Acquired on the Phoenix ICON. Pediatric wide-field fundus photograph.
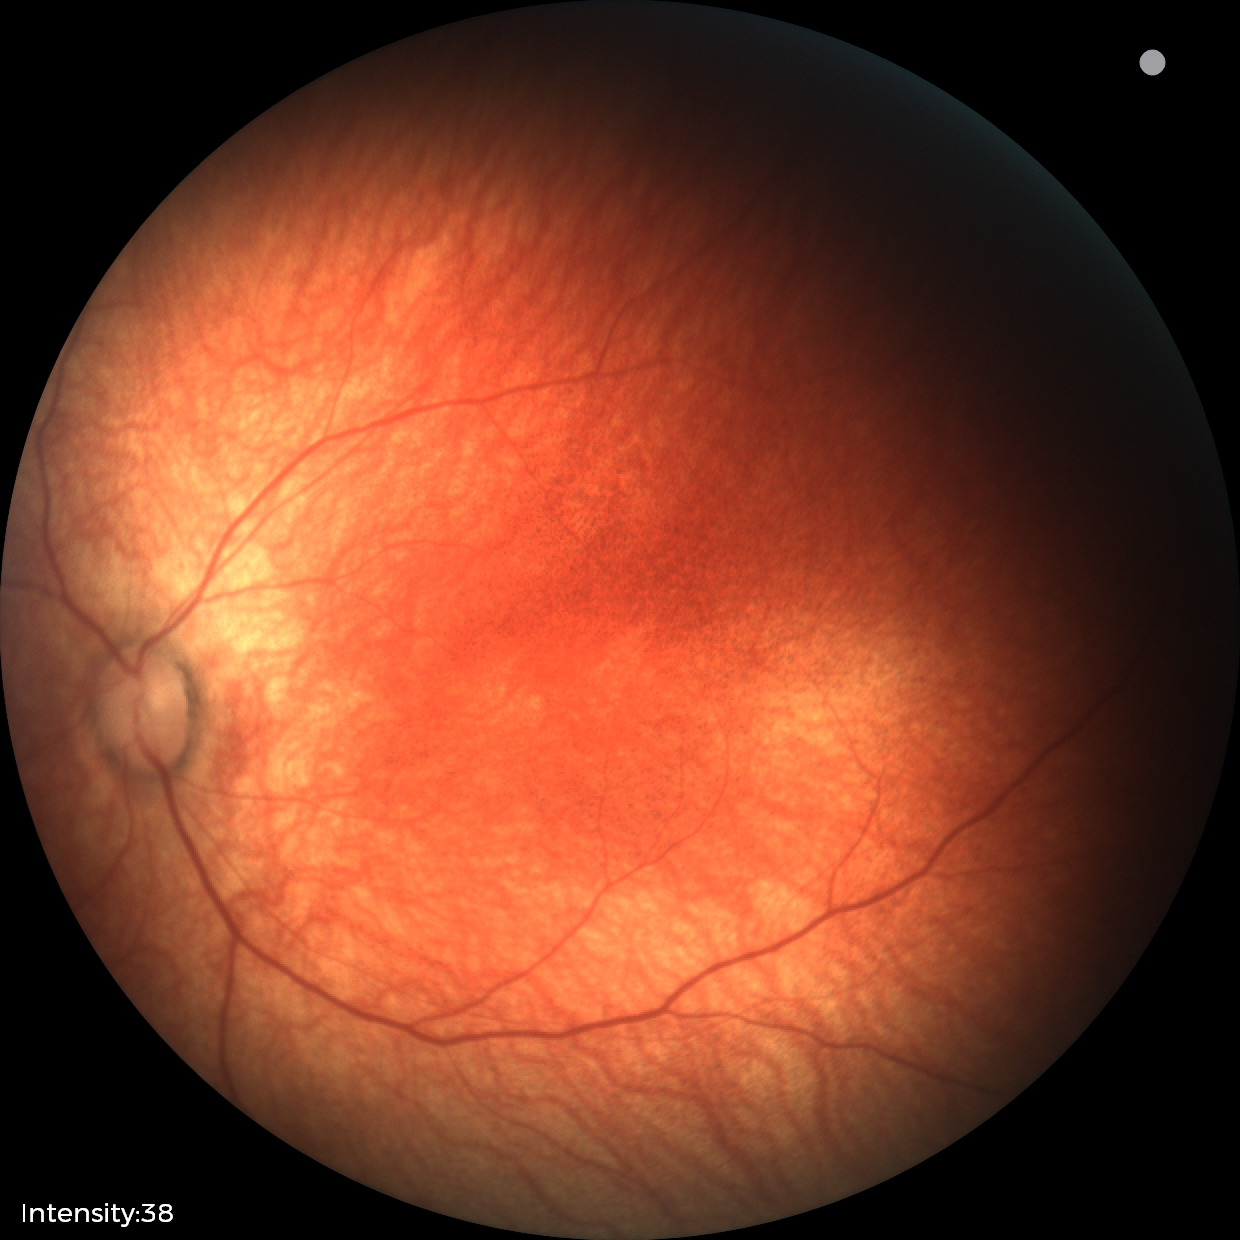 Examination with physiological retinal findings.